Infant wide-field fundus photograph
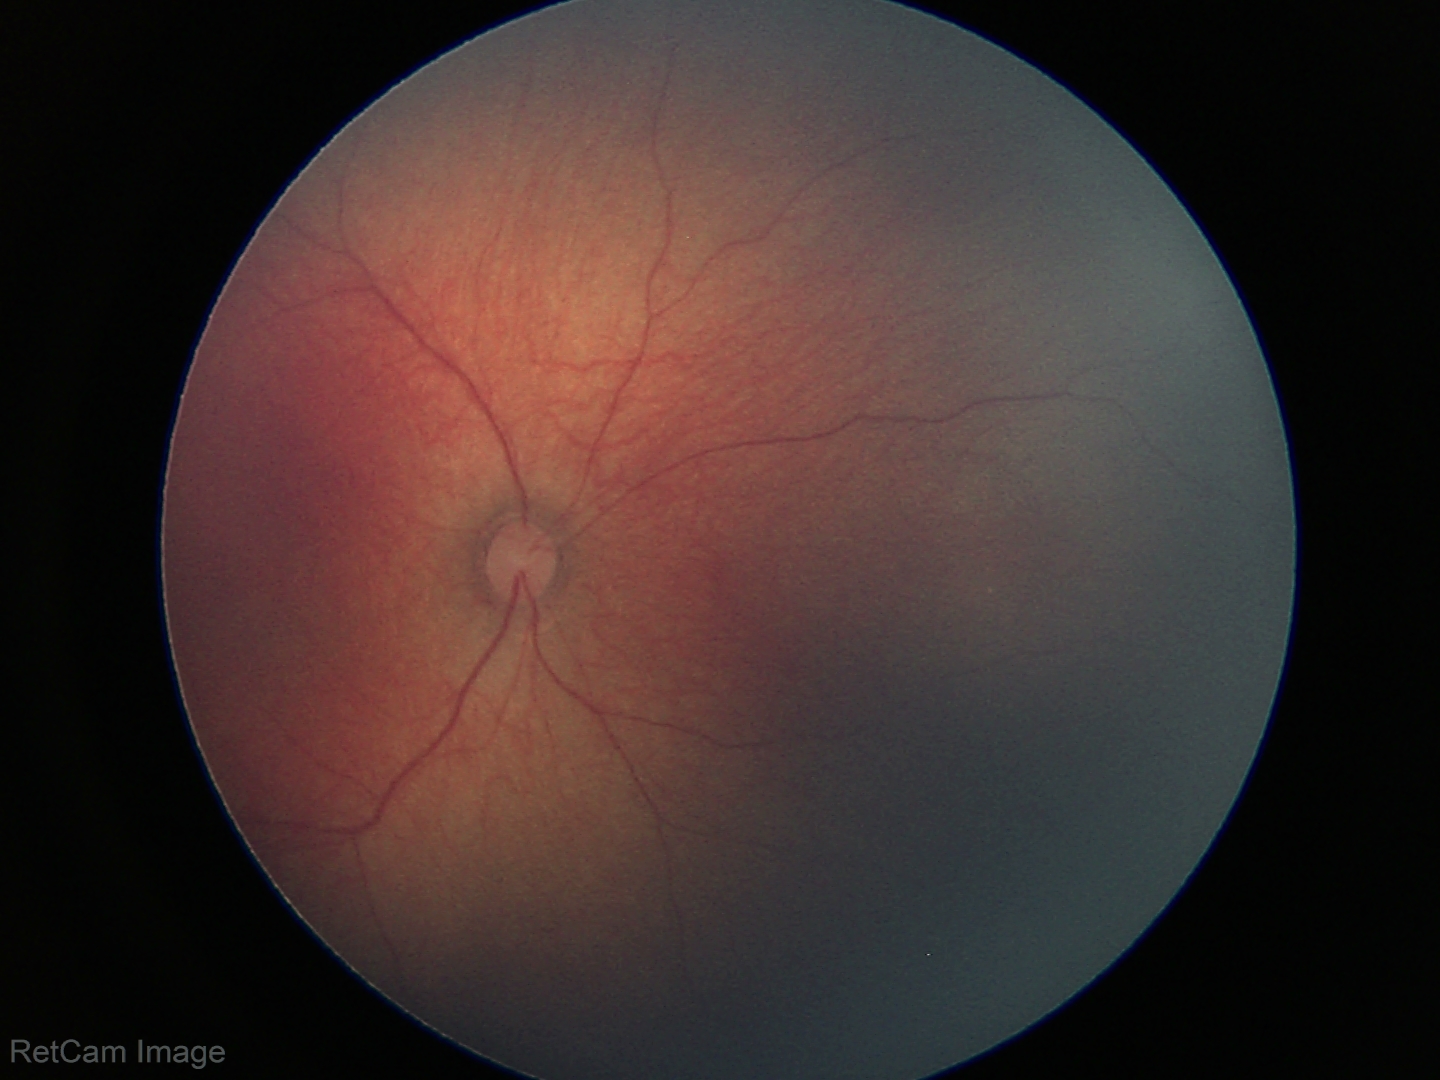
Screening diagnosis: normal retinal appearance.